Nonmydriatic fundus photograph; image size 848x848:
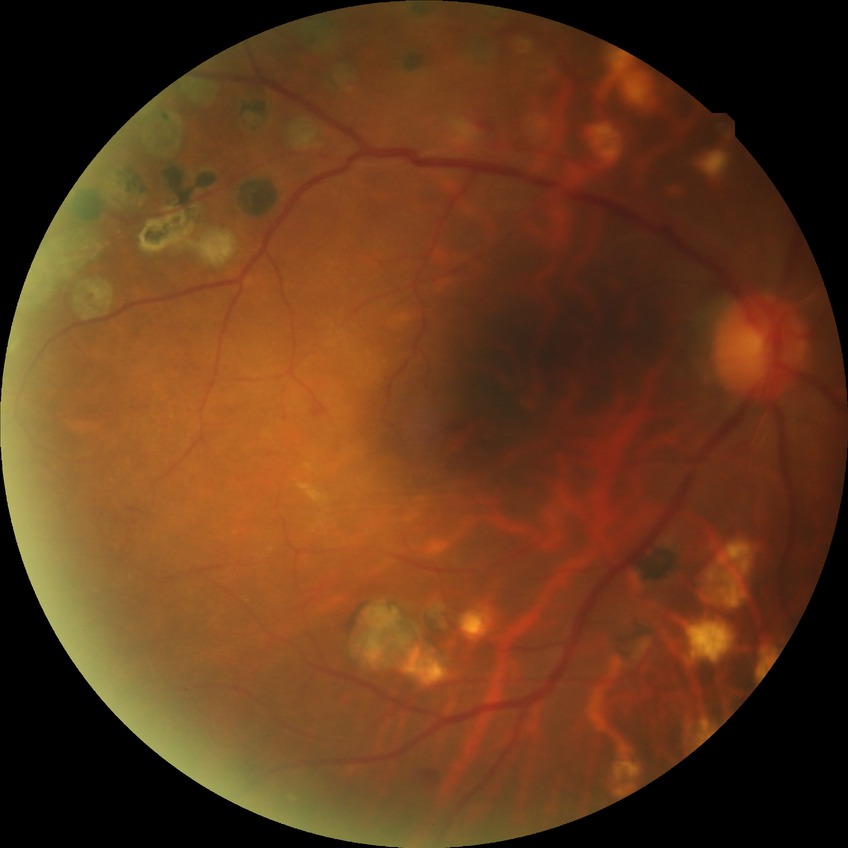
Diabetic retinopathy (DR): pre-proliferative diabetic retinopathy (PPDR).